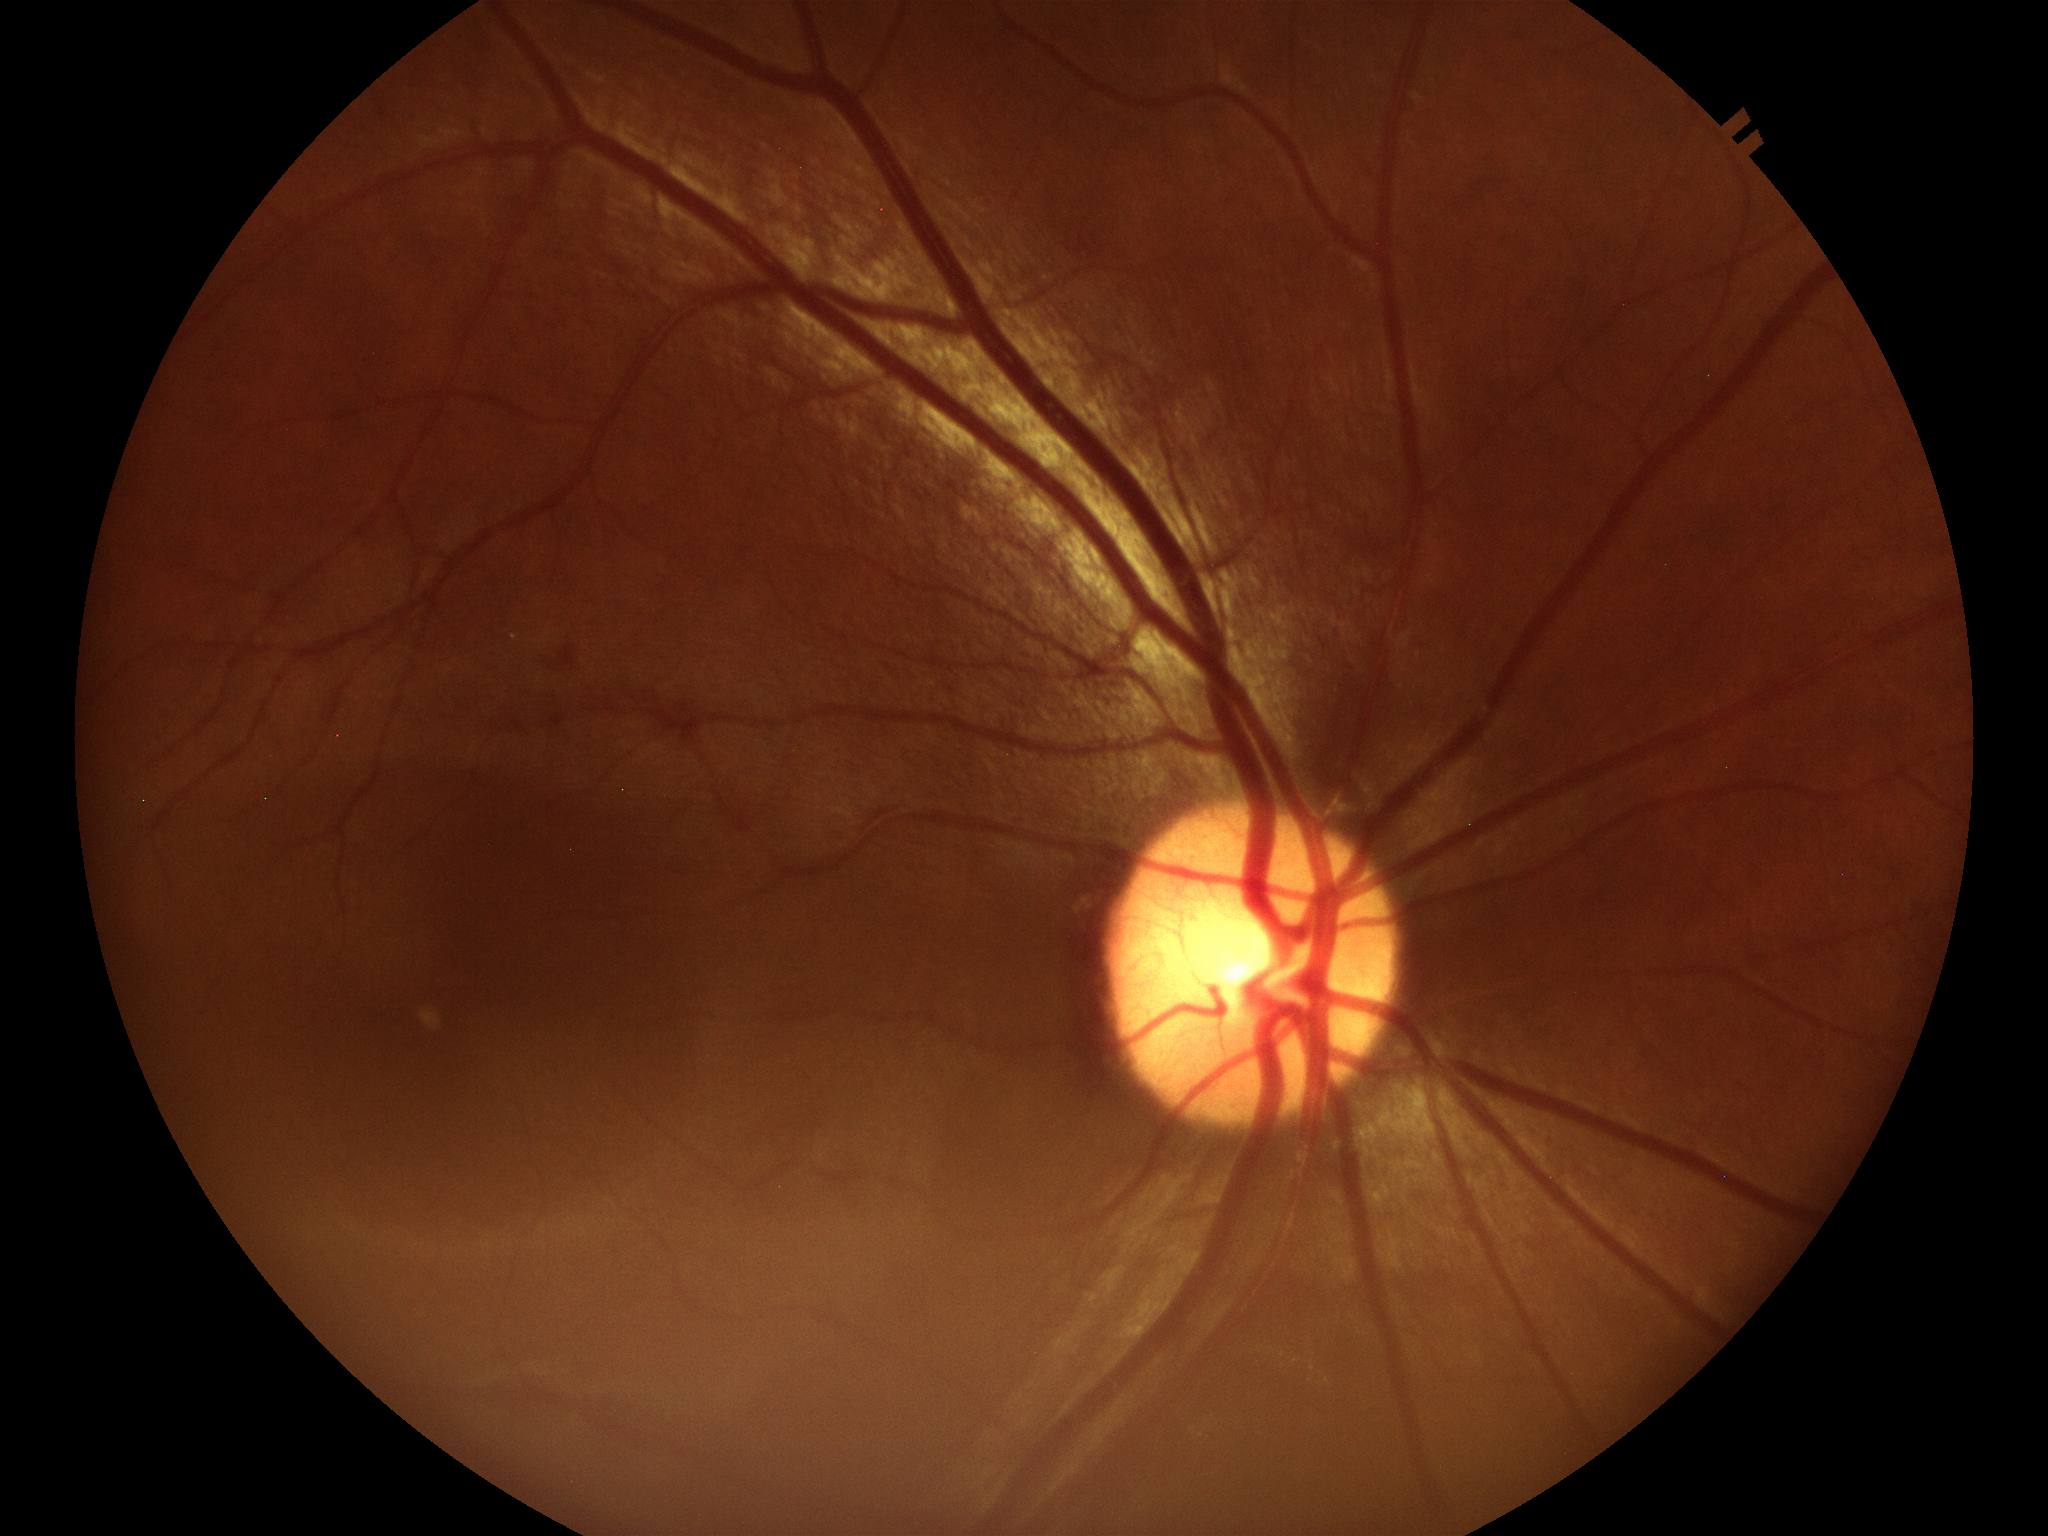

area cup-to-disc ratio = 0.26
vertical cup-disc ratio = 0.50
Glaucoma assessment = no suspicious findings